No pharmacologic dilation · 848 x 848 pixels · NIDEK AFC-230 fundus camera:
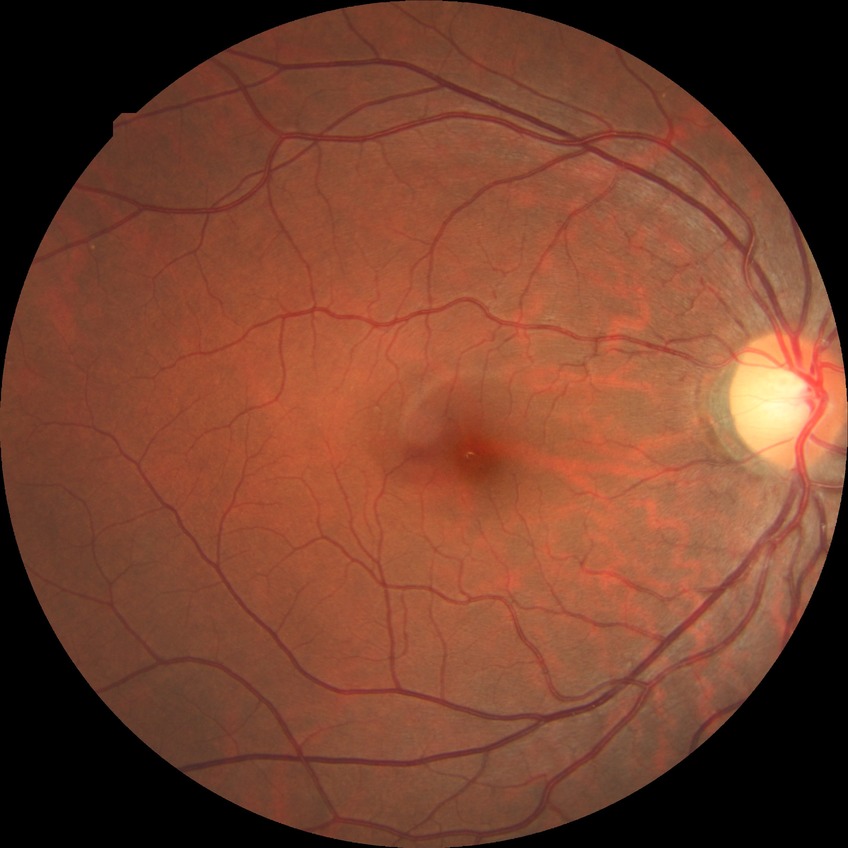 Retinopathy stage: no diabetic retinopathy.